Retinal fundus photograph — 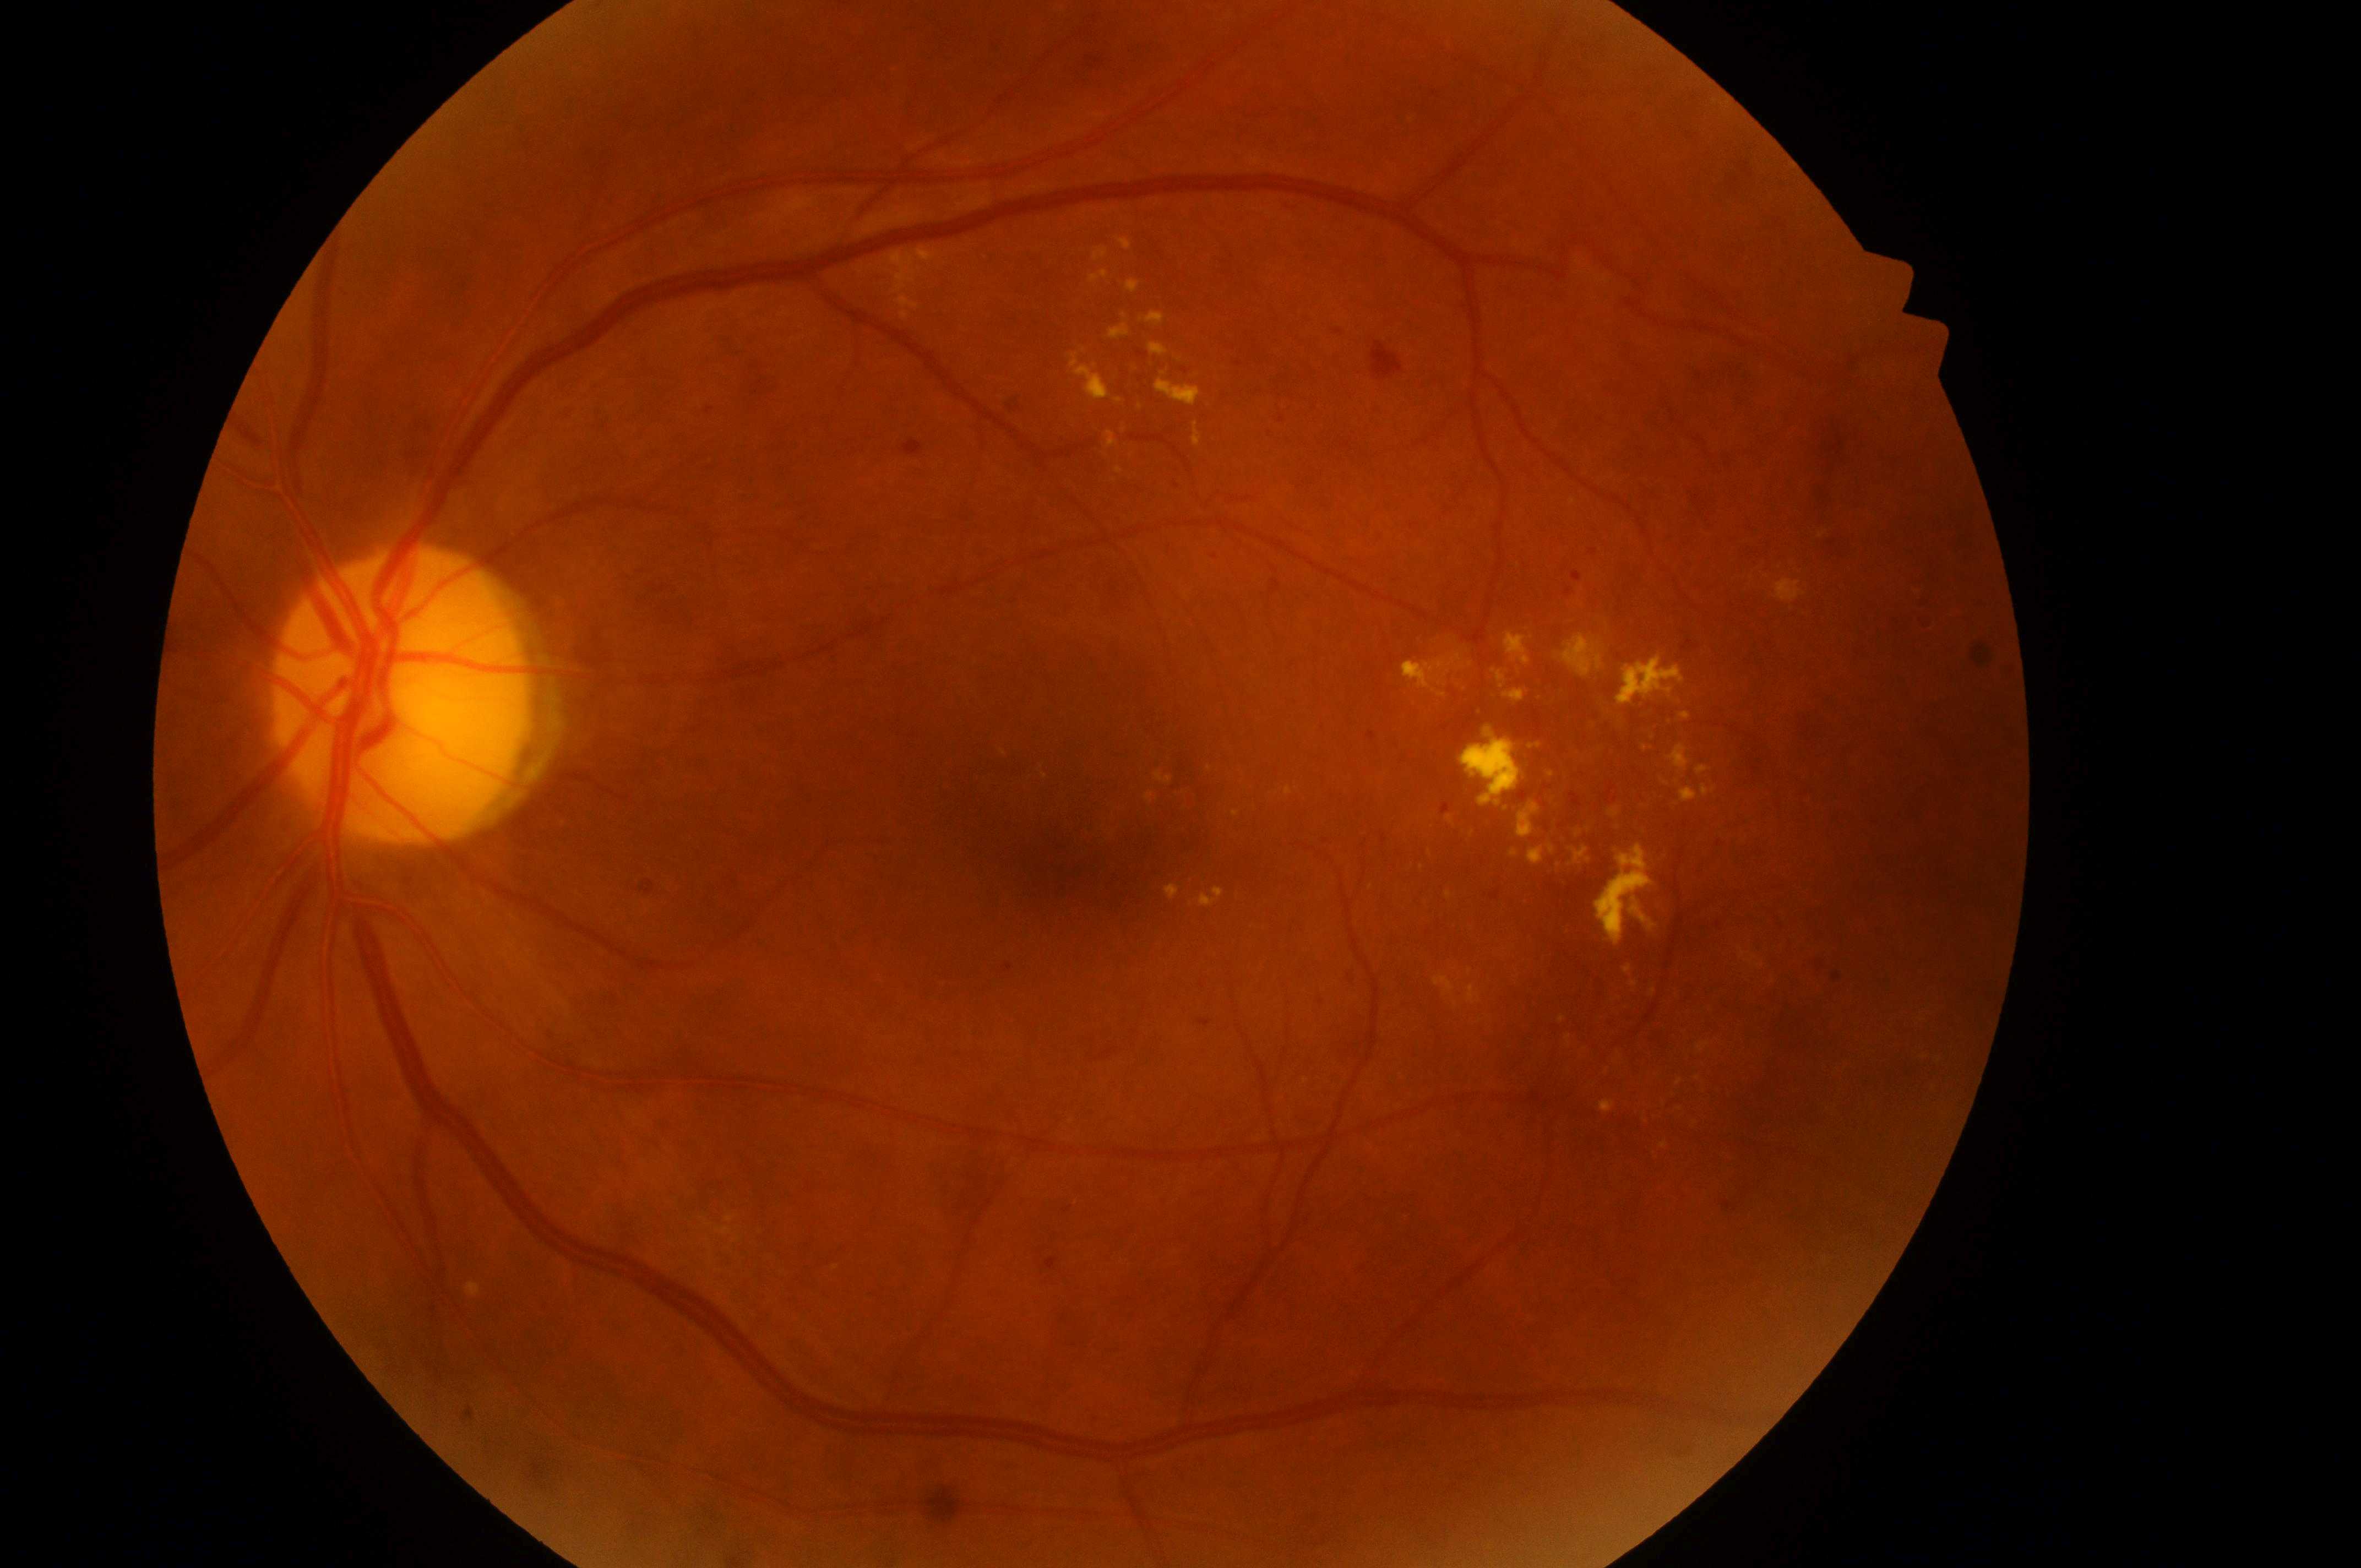

Imaged eye: left eye. Diabetic retinopathy (DR) is 3 — more than 20 intraretinal hemorrhages in each of 4 quadrants, definite venous beading in 2 or more quadrants, or prominent intraretinal microvascular abnormalities in 1 or more quadrants, with no signs of proliferative retinopathy. Diabetic macular edema (DME): 2 — hard exudates within one disc diameter of the macula center. Foveal center: x=1073, y=845. Optic disk located at x=398, y=707.